NIDEK AFC-230 fundus camera · without pupil dilation.
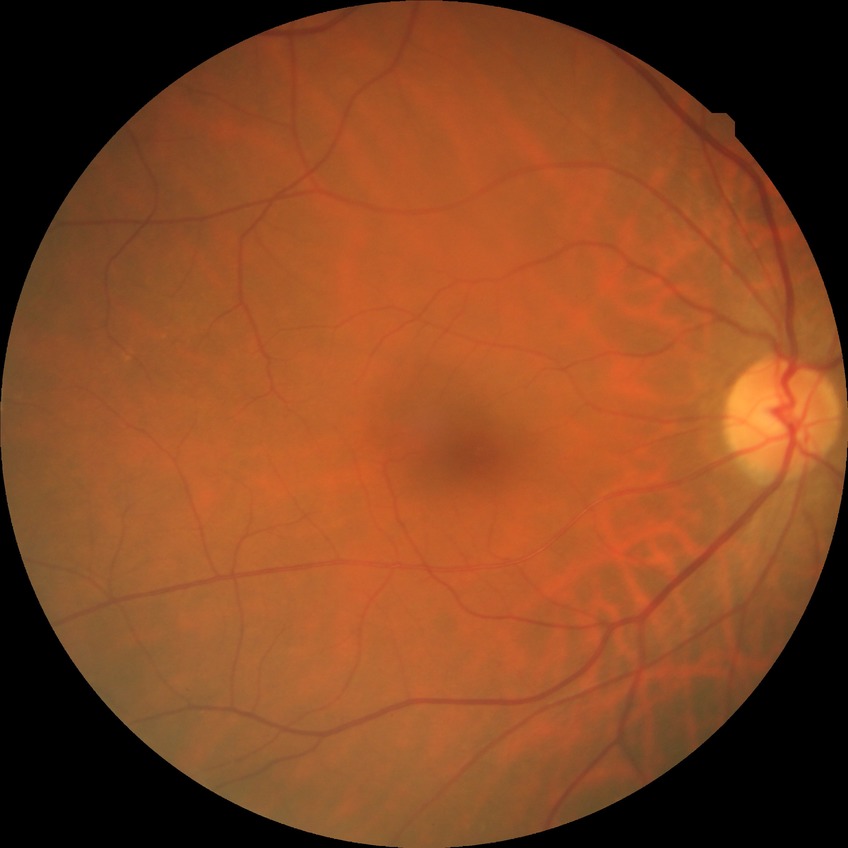

modified Davis grading=no diabetic retinopathy.